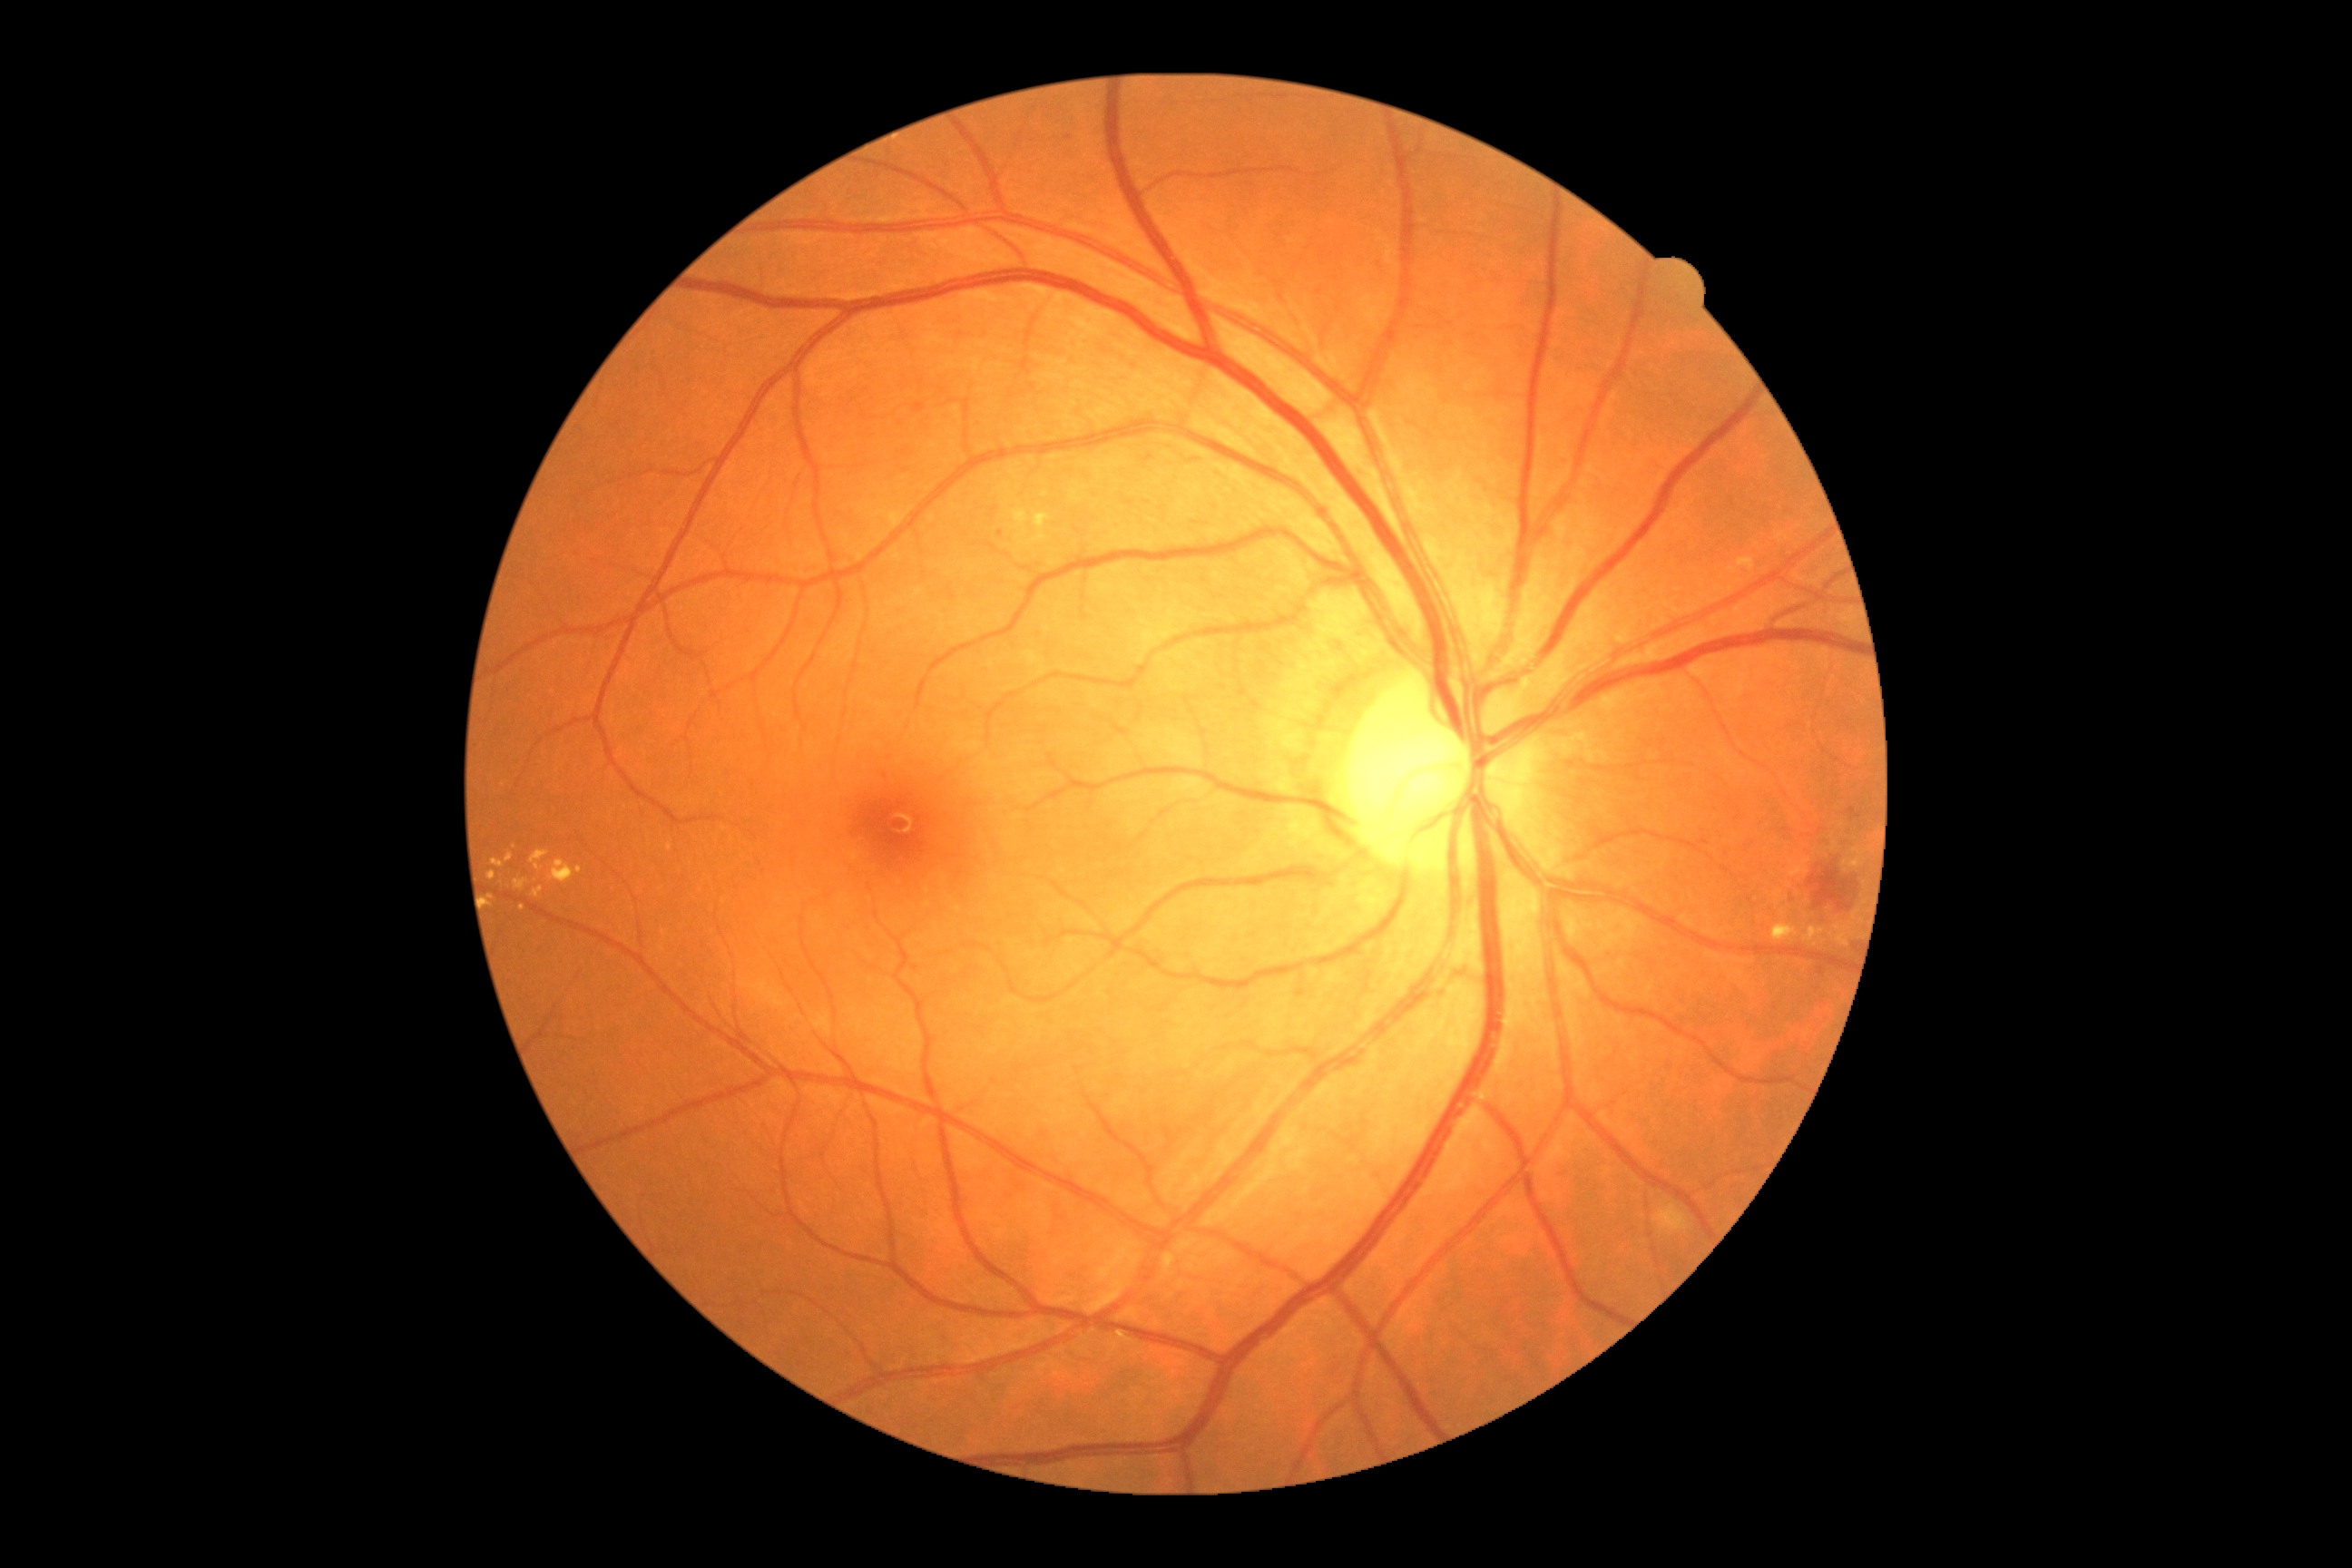 DR severity: grade 2.